Wide-field contact fundus photograph of an infant
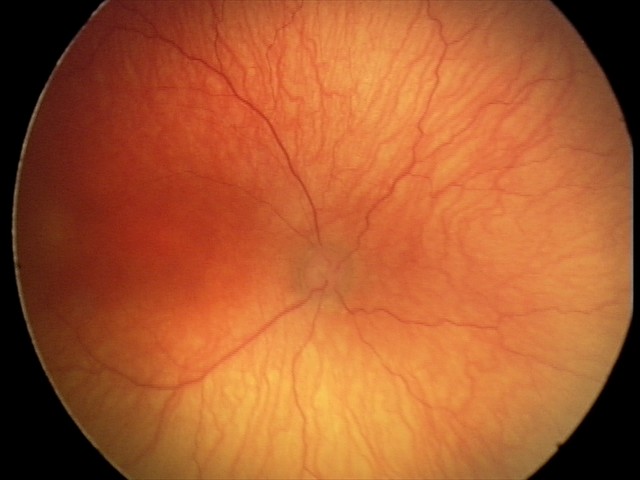 Examination diagnosed as A-ROP (aggressive ROP).
Plus disease present.